2352x1568, 45° FOV — 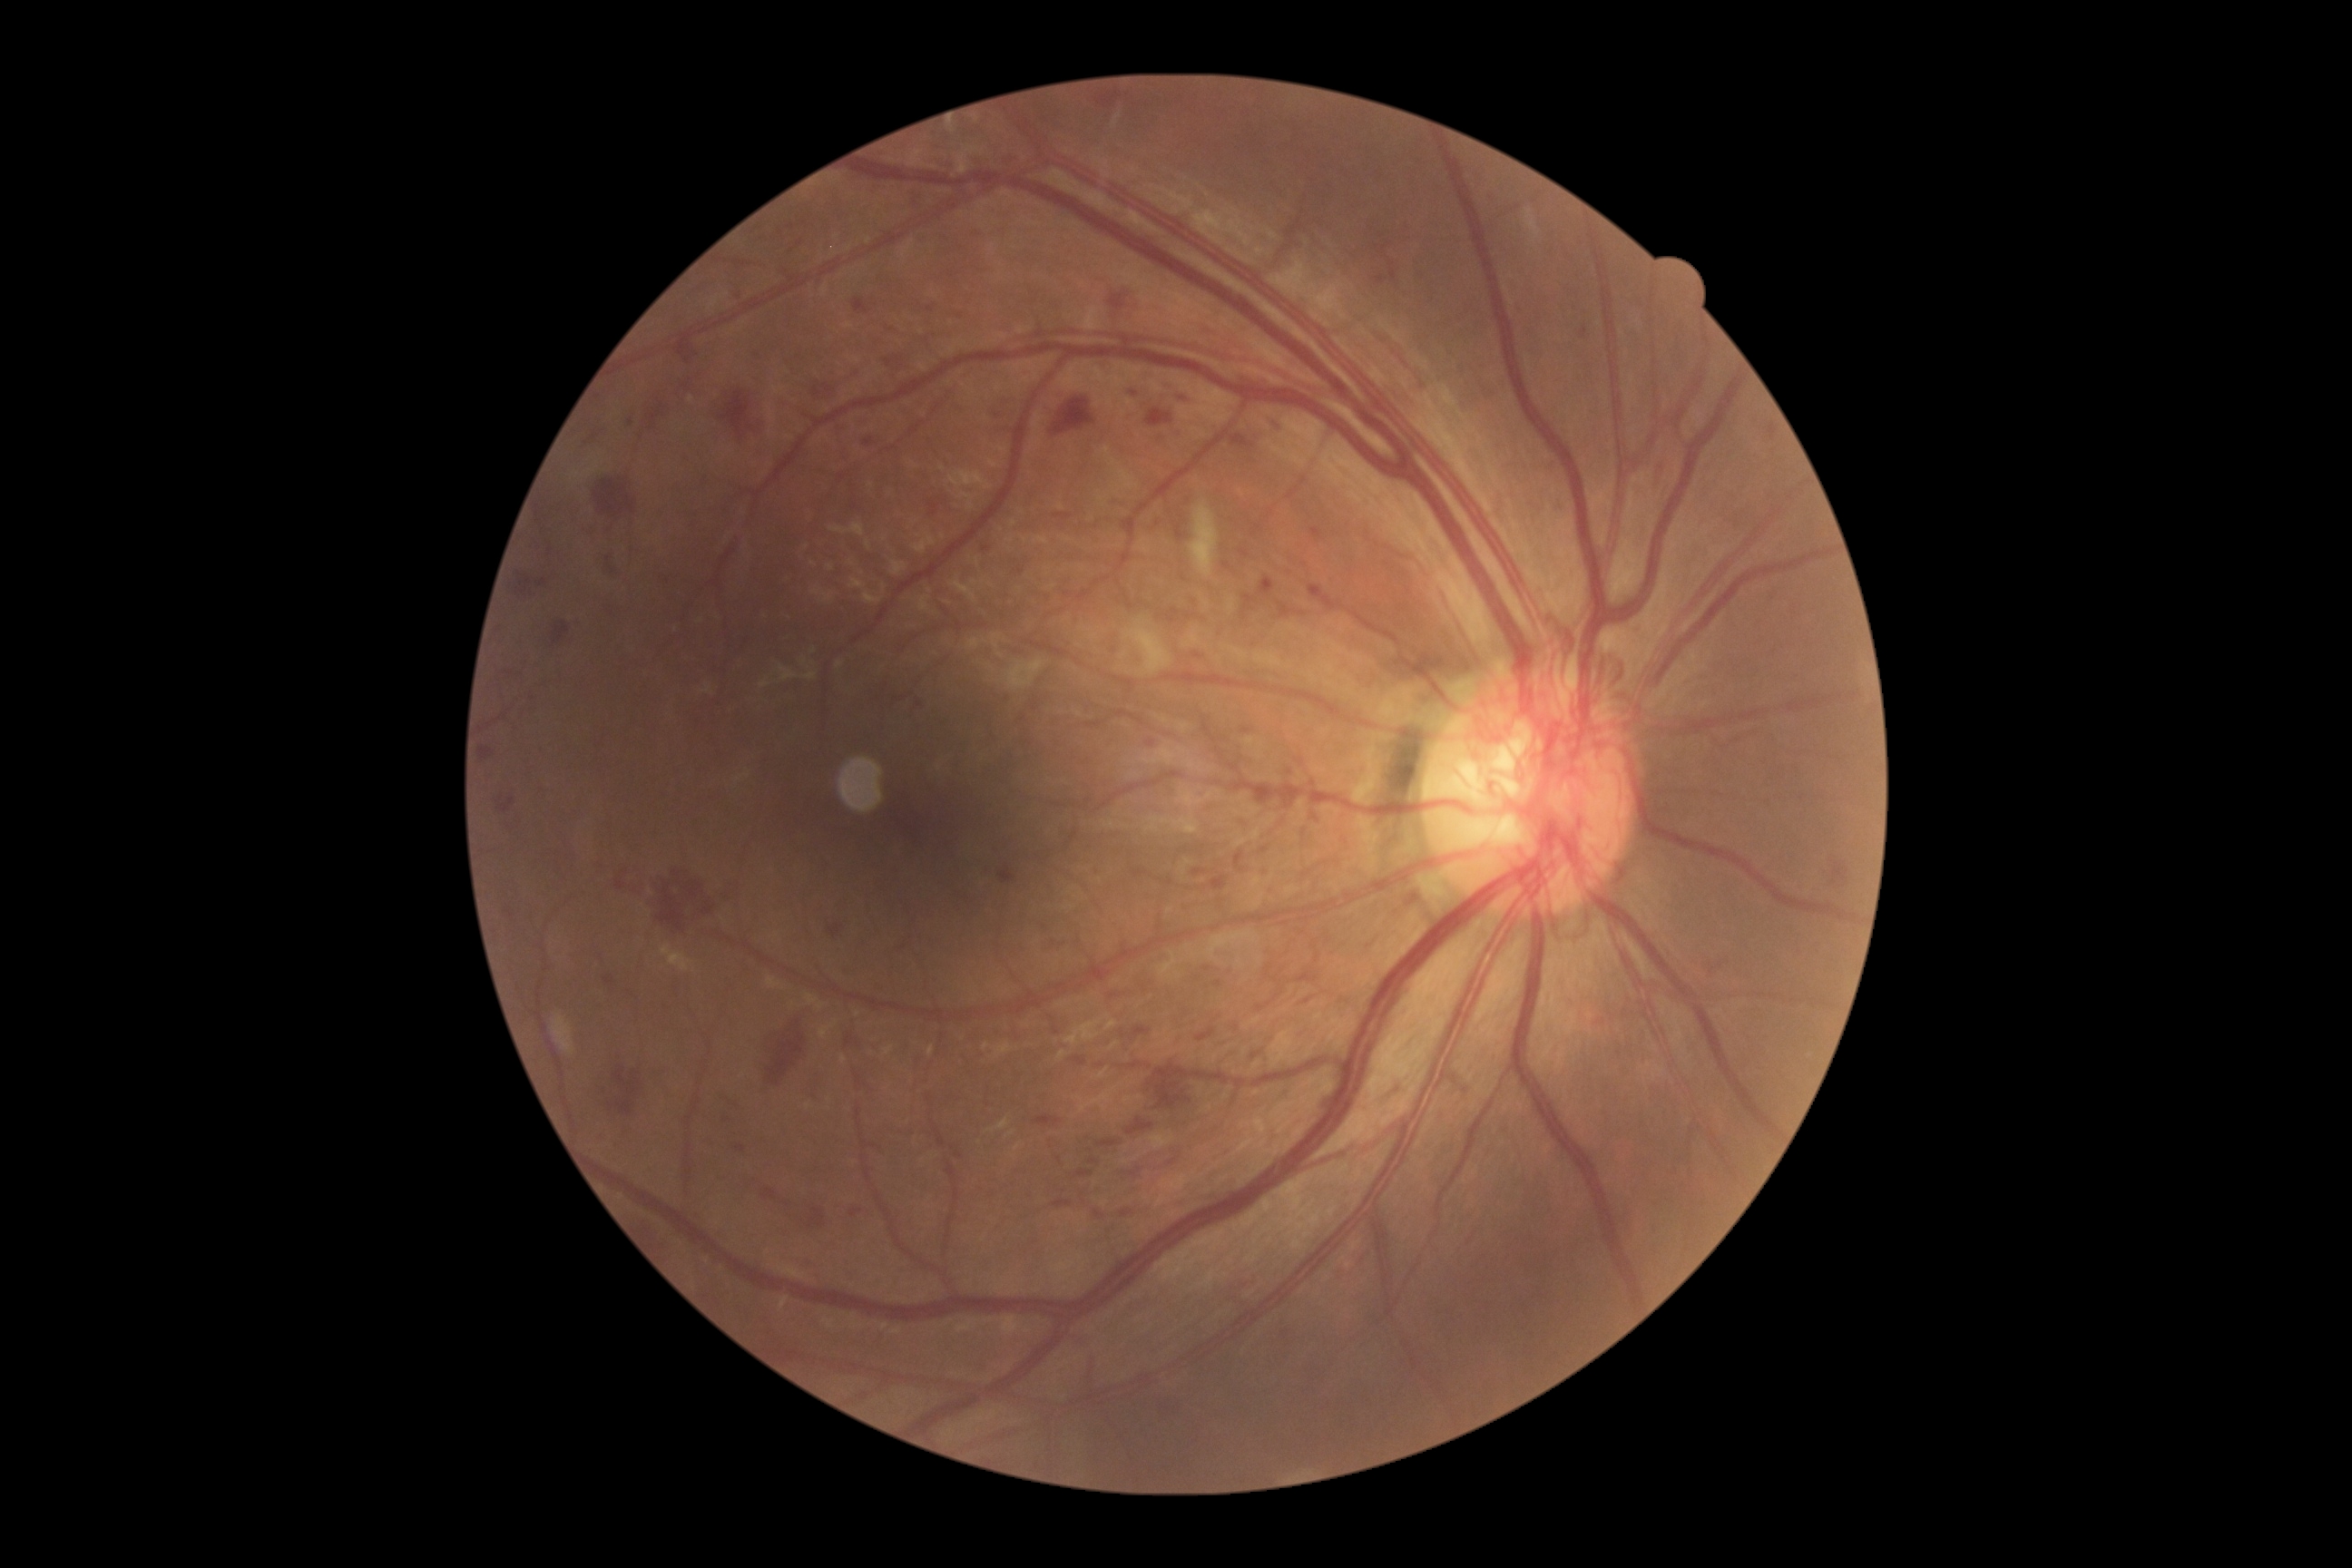
<lesions partial="true">
  <dr_grade>4</dr_grade>
  <he partial="true"><bbox>725, 881, 741, 901</bbox>; <bbox>885, 353, 912, 373</bbox>; <bbox>720, 391, 750, 440</bbox>; <bbox>1297, 972, 1318, 983</bbox>; <bbox>1130, 1168, 1142, 1179</bbox>; <bbox>910, 188, 921, 206</bbox>; <bbox>767, 1034, 805, 1088</bbox>; <bbox>496, 796, 516, 814</bbox>; <bbox>1097, 1141, 1121, 1148</bbox>; <bbox>865, 436, 876, 447</bbox>; <bbox>1173, 393, 1195, 406</bbox>; <bbox>1168, 1159, 1177, 1166</bbox>; <bbox>553, 622, 571, 645</bbox>; <bbox>1034, 1115, 1061, 1126</bbox>; <bbox>1073, 1059, 1086, 1066</bbox>; <bbox>730, 289, 741, 302</bbox>; <bbox>1126, 1117, 1155, 1137</bbox>; <bbox>1235, 852, 1244, 868</bbox></he>
  <he_small>Point(503, 624); Point(1084, 1202)</he_small>
</lesions>